Diabetic retinopathy graded by the modified Davis classification:
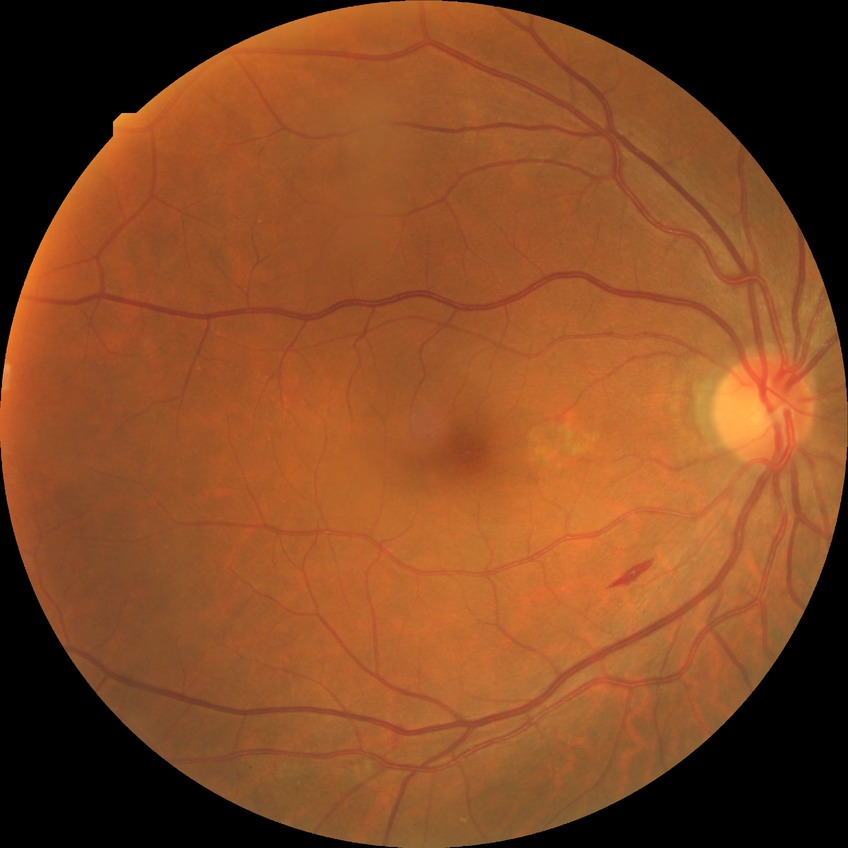 Findings:
– diabetic retinopathy (DR) — PPDR (pre-proliferative diabetic retinopathy)